1536 by 1152 pixels. Color fundus image. 45° field of view: 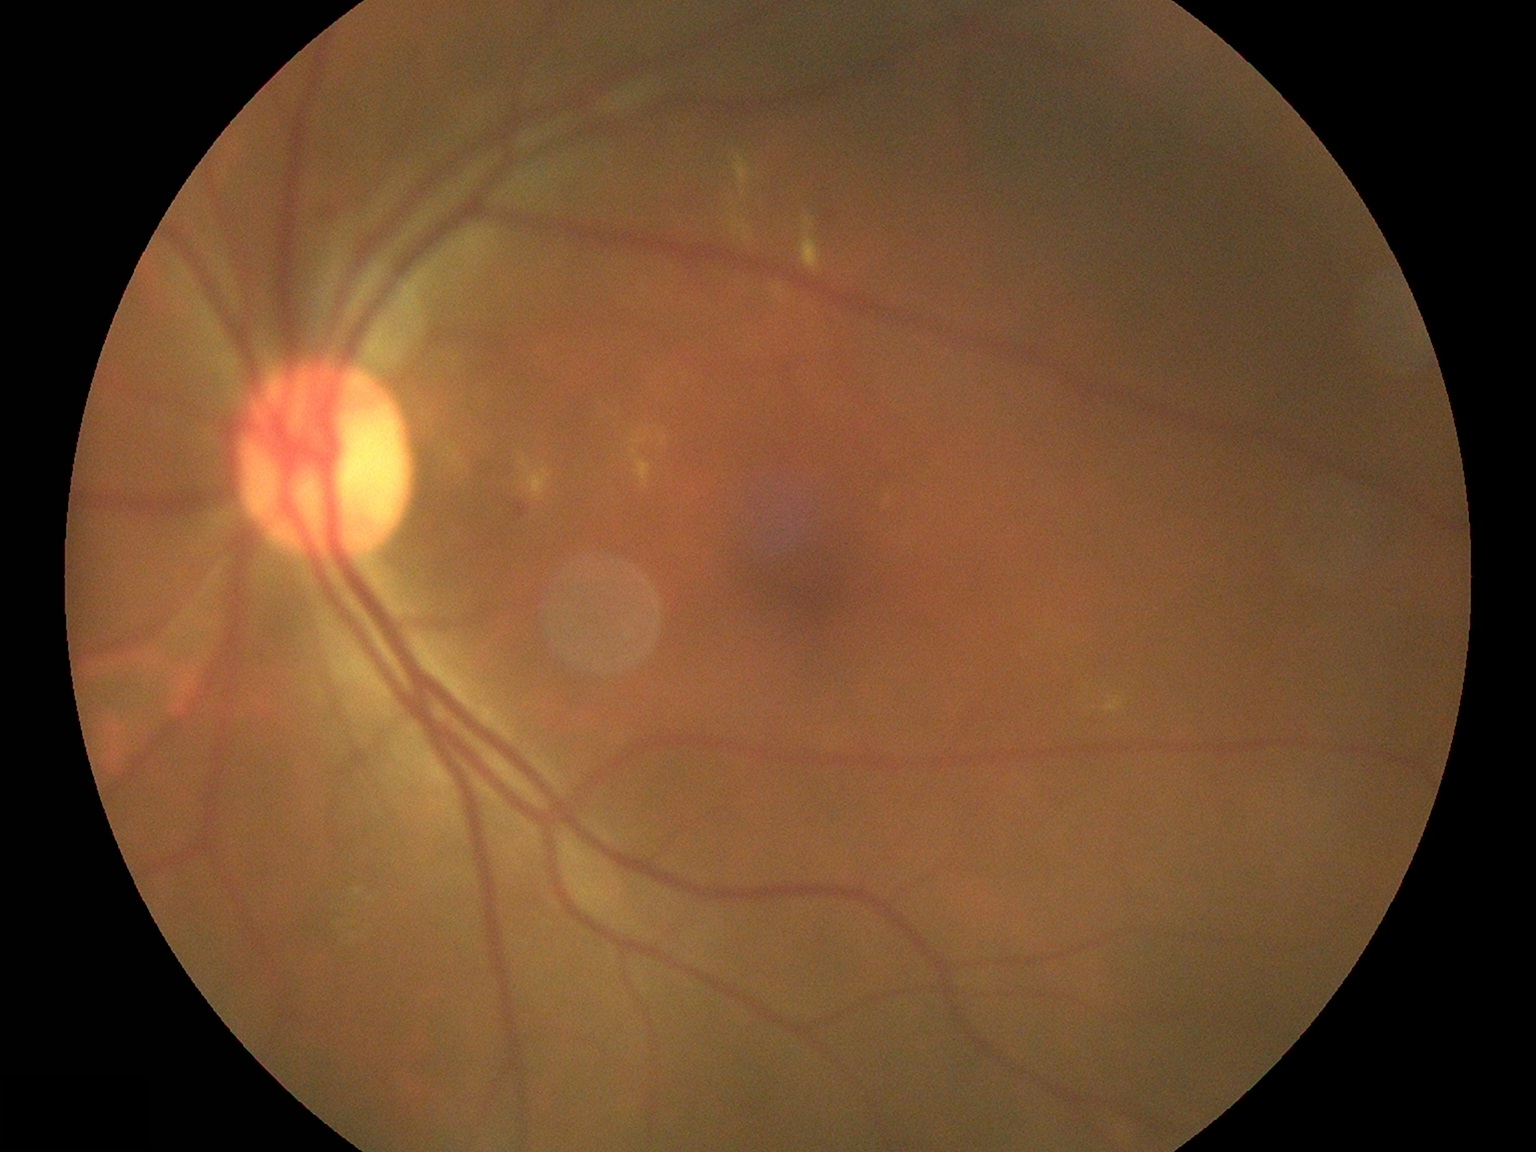
DR grade: 2 (moderate NPDR) — more than just microaneurysms but less than severe NPDR.